Image size 1924x1556. FOV: 50 degrees. Tabletop color fundus camera image — 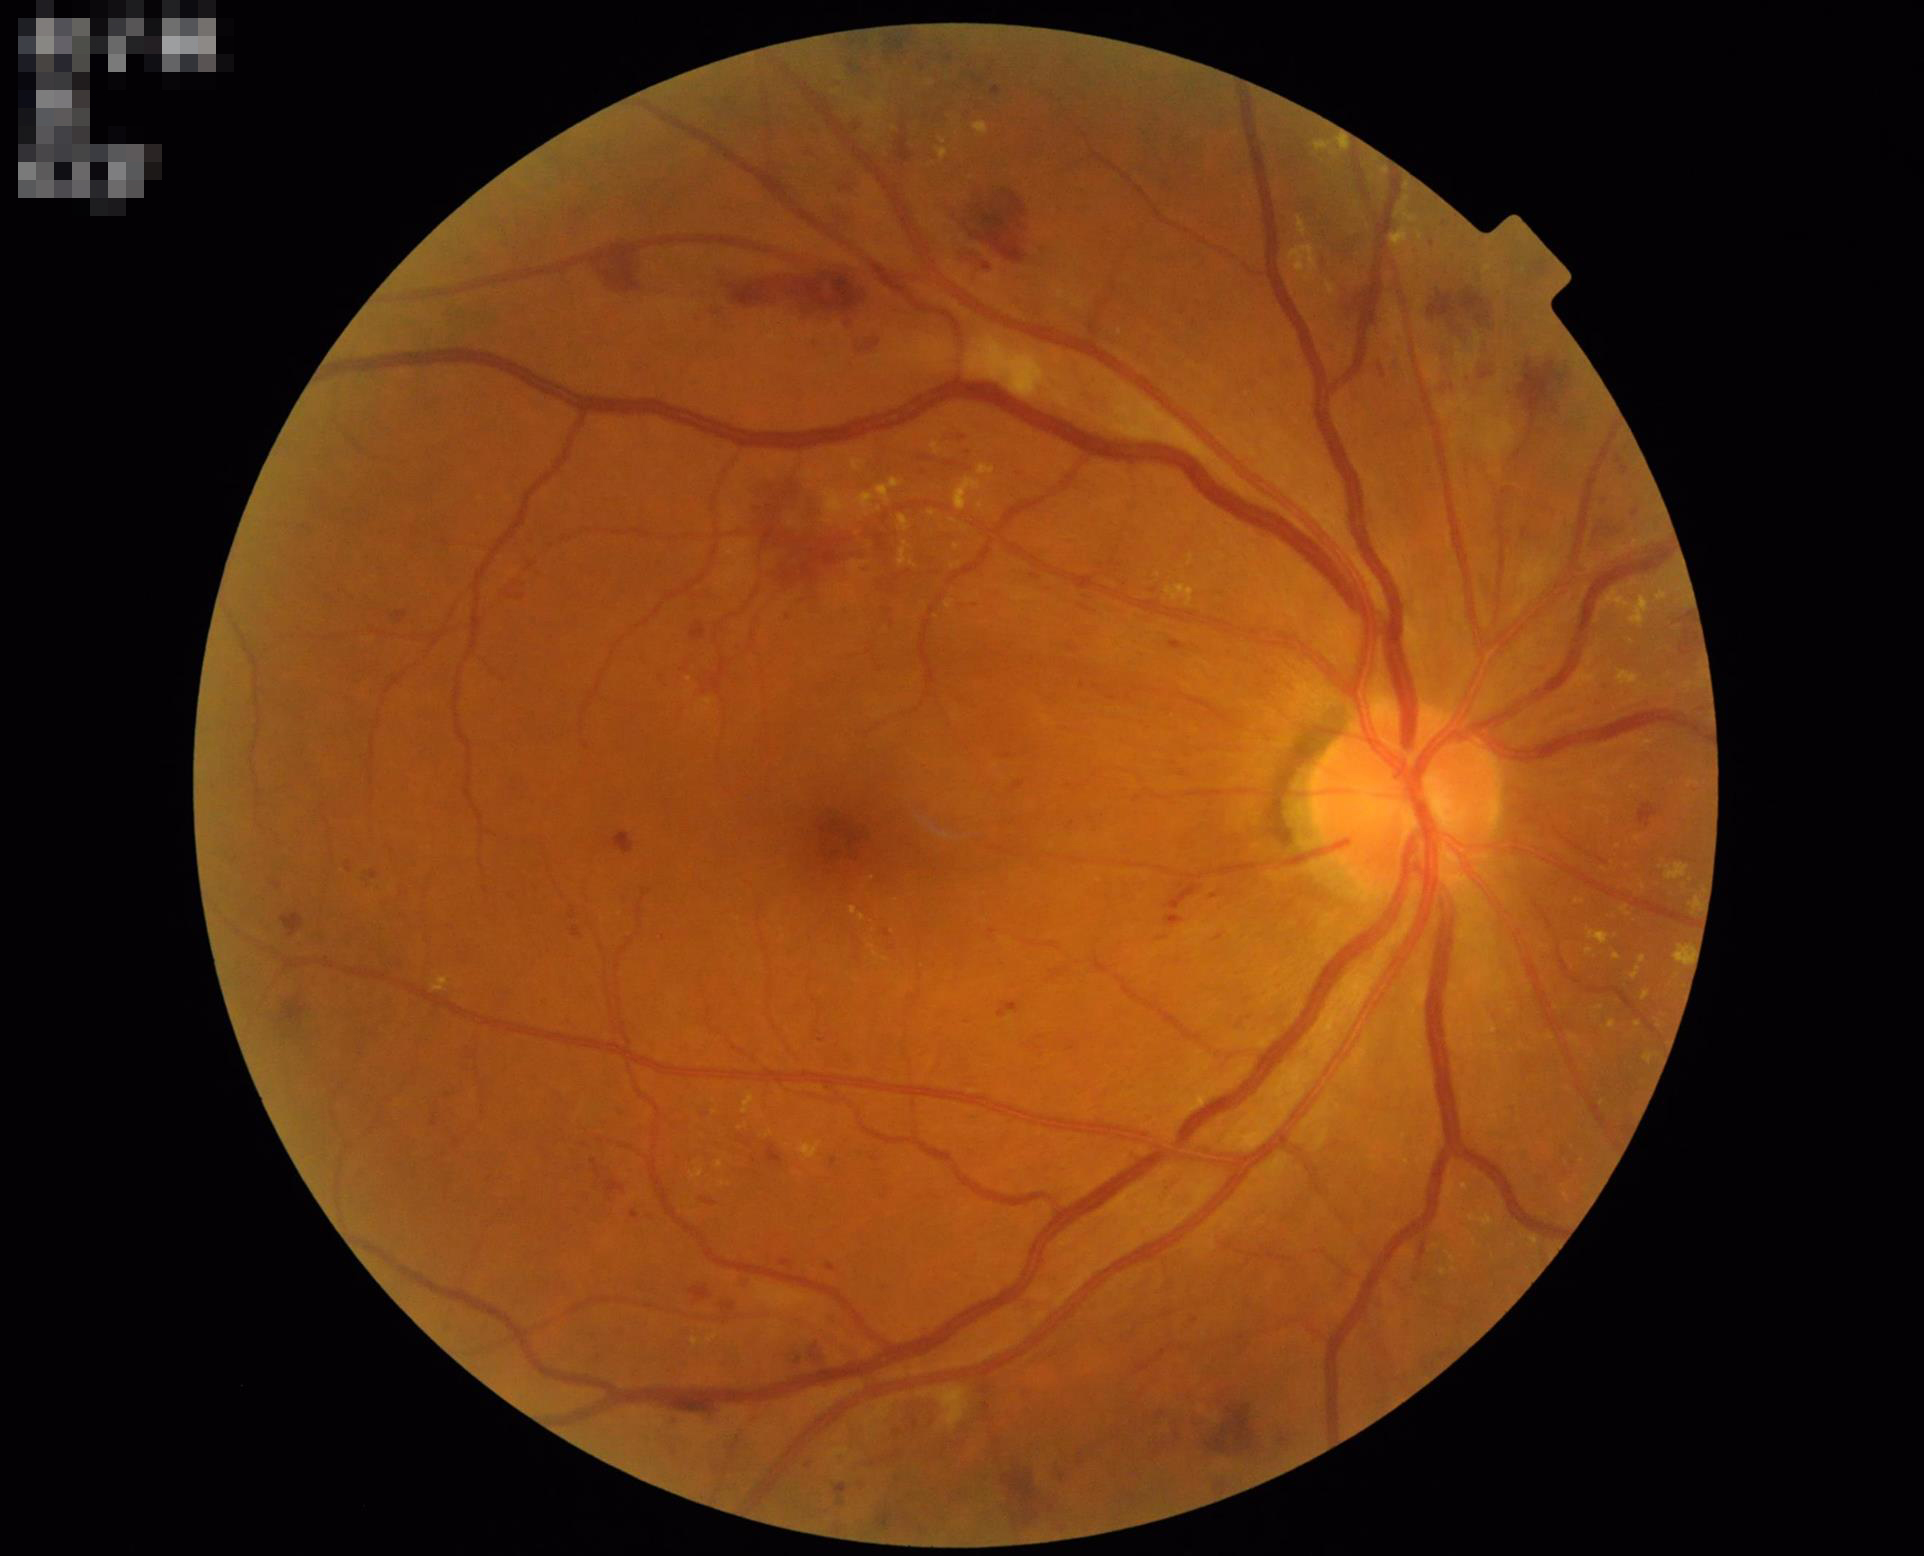

Even illumination with no color cast. Overall quality is good and the image is gradable. Optic disc, vessels, and background are in focus. Vessels and details are readily distinguishable.